Retinal fundus photograph:
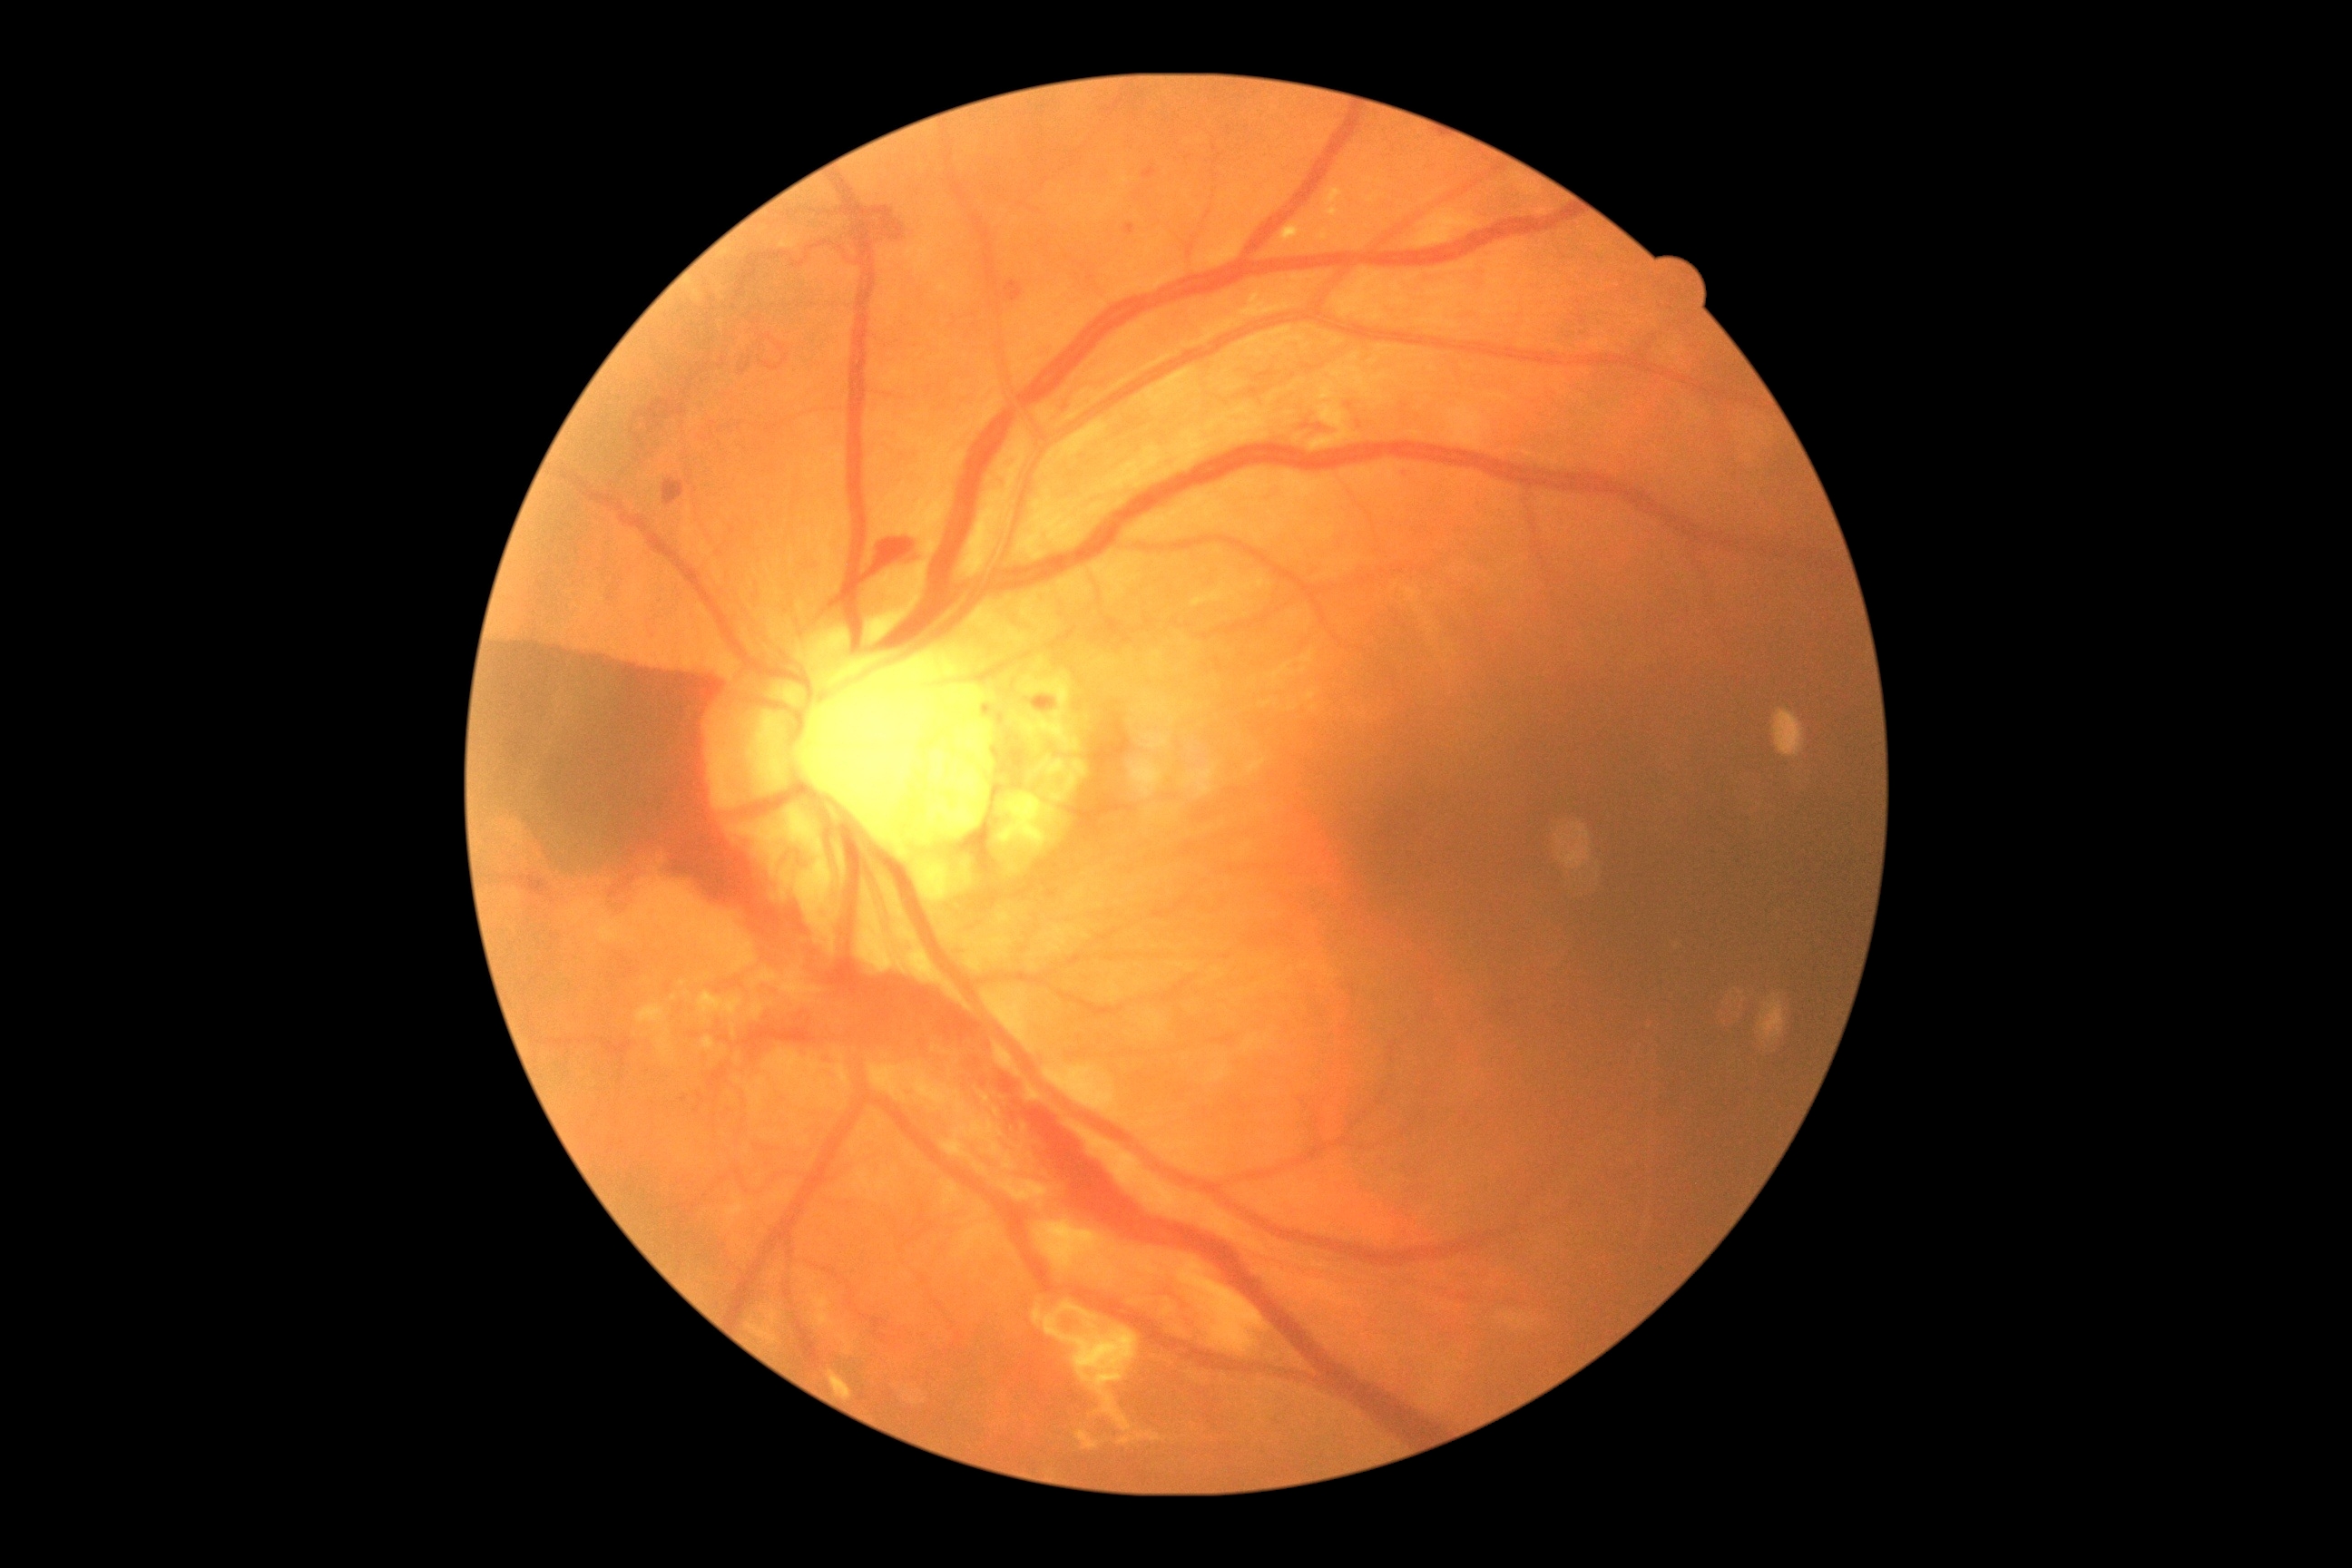
diabetic retinopathy@4.